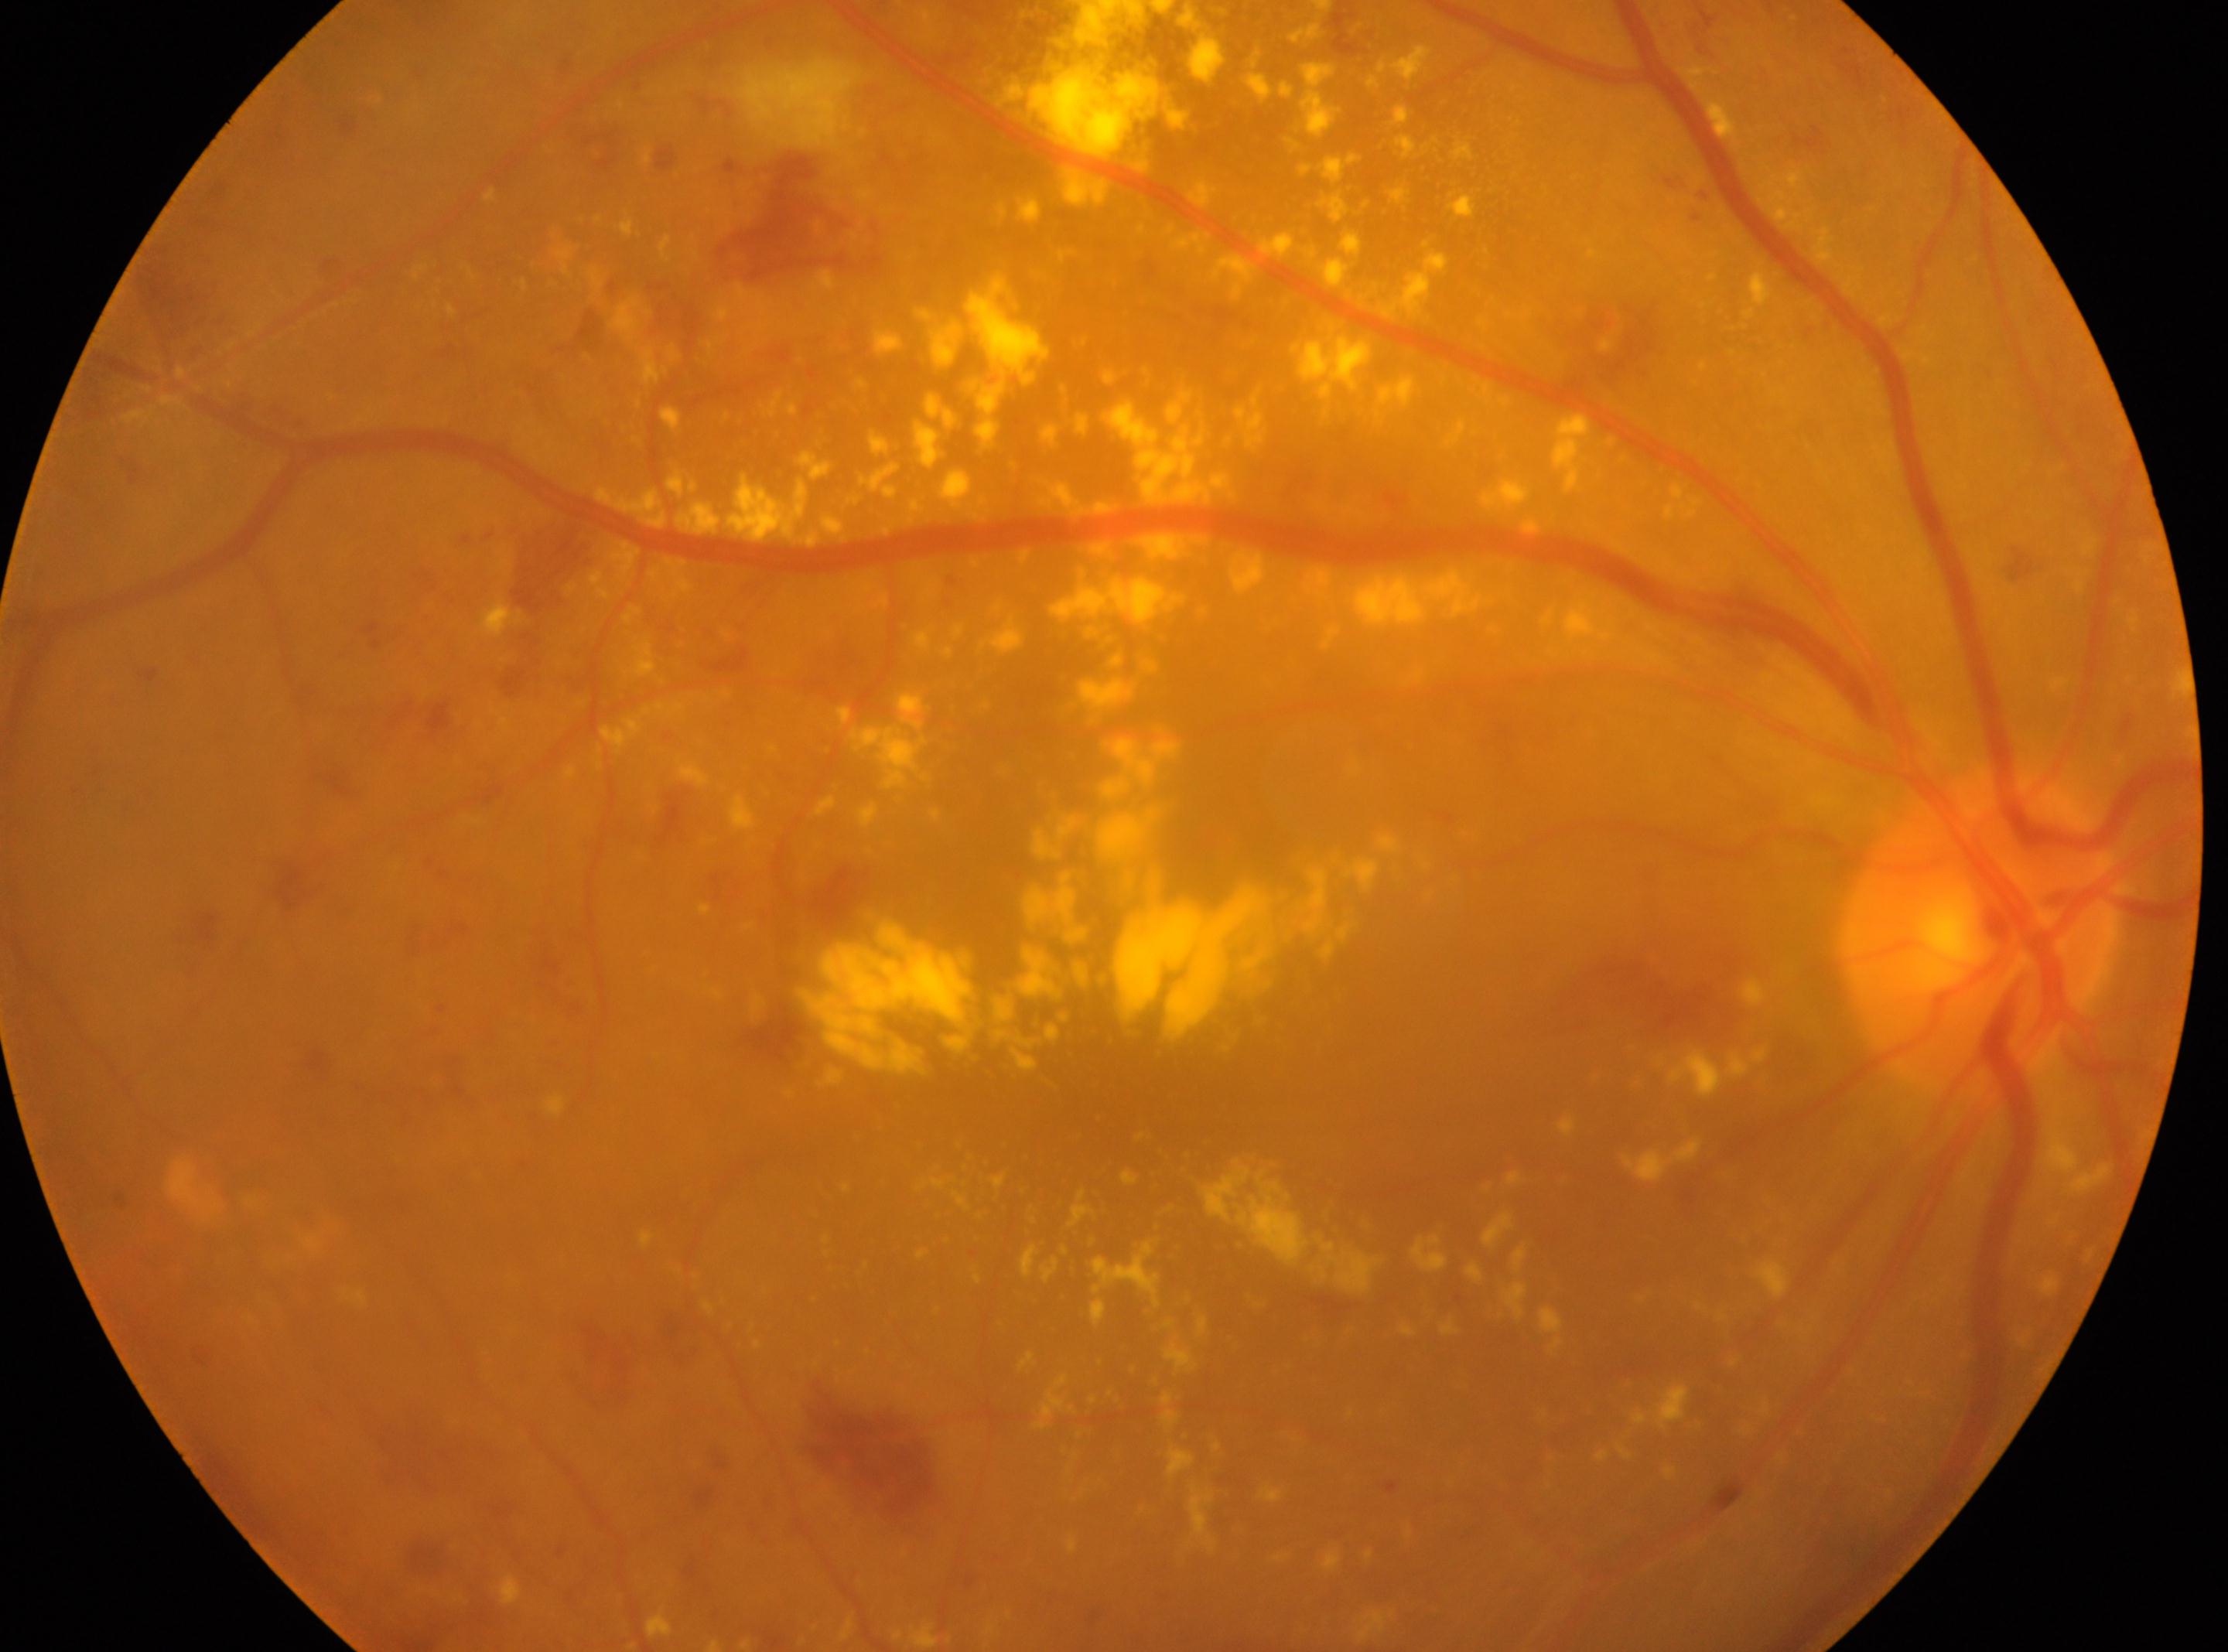

foveal center: 1112, 1111 | DR stage: grade 2 (moderate NPDR) — more than just microaneurysms but less than severe NPDR | eye: OD | optic disc: 1980, 931.